2352x1568px:
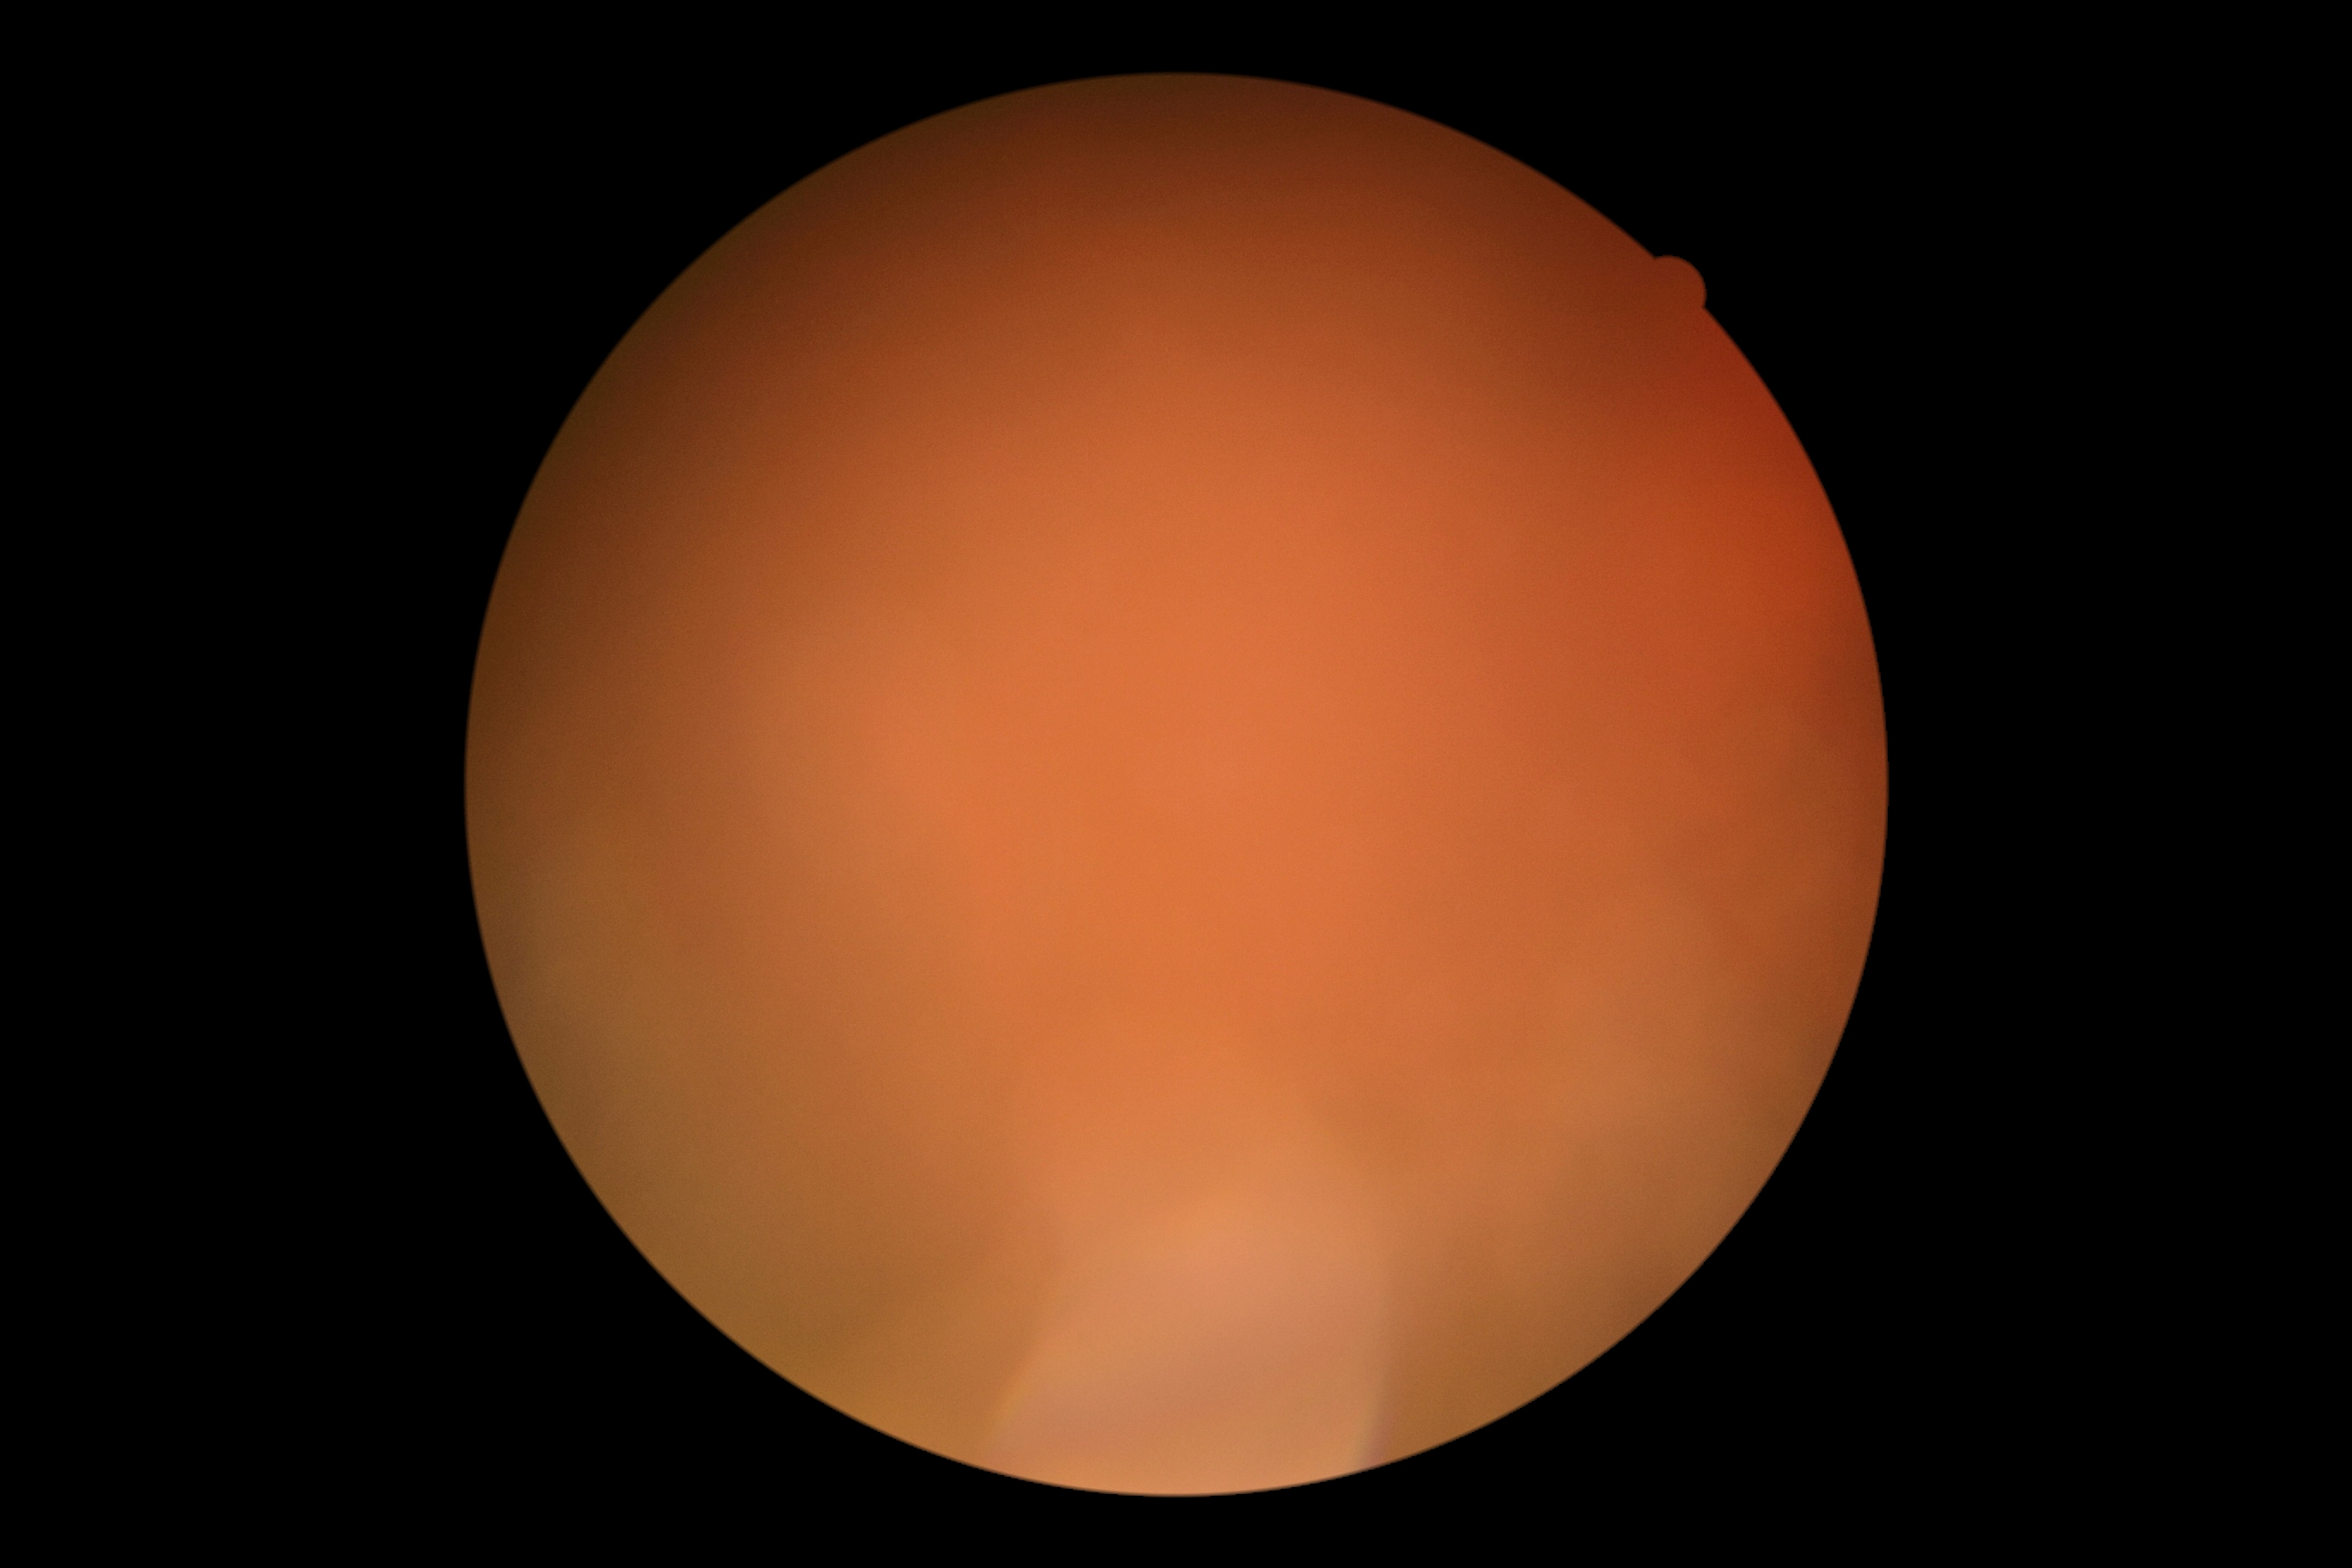 Diabetic retinopathy is ungradable.